Color fundus image; 1536 by 1152 pixels — 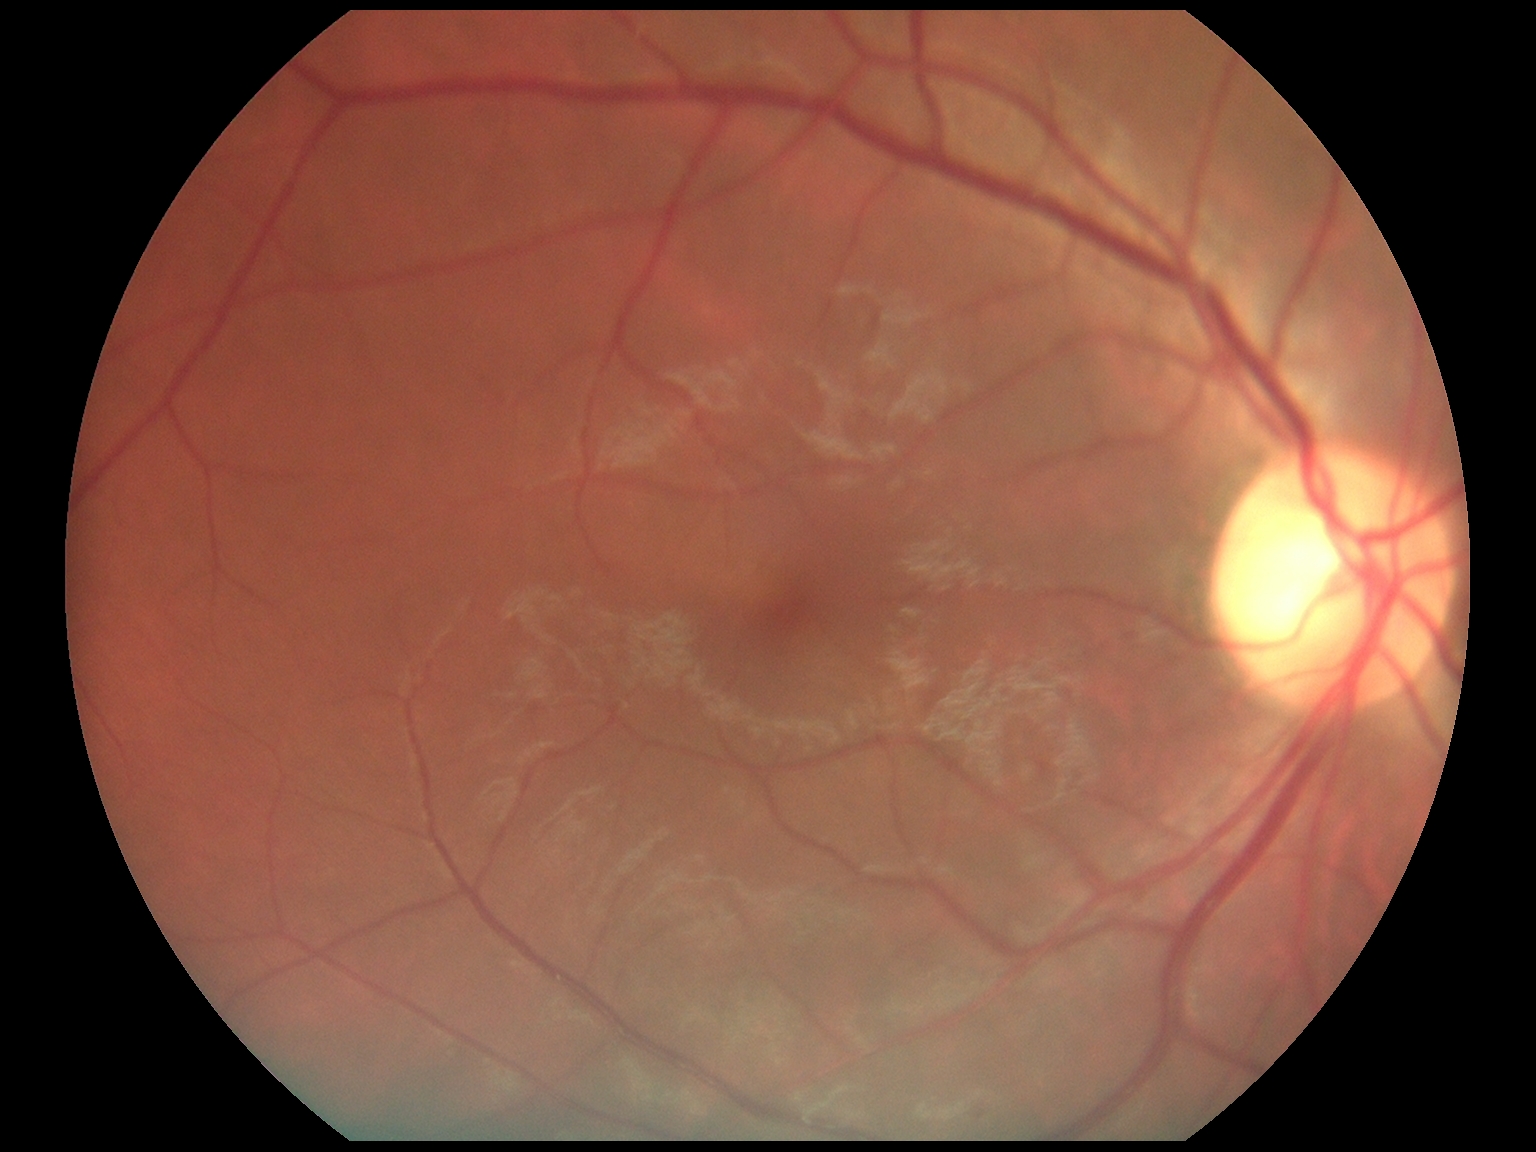 – DR — 0